2048x1536:
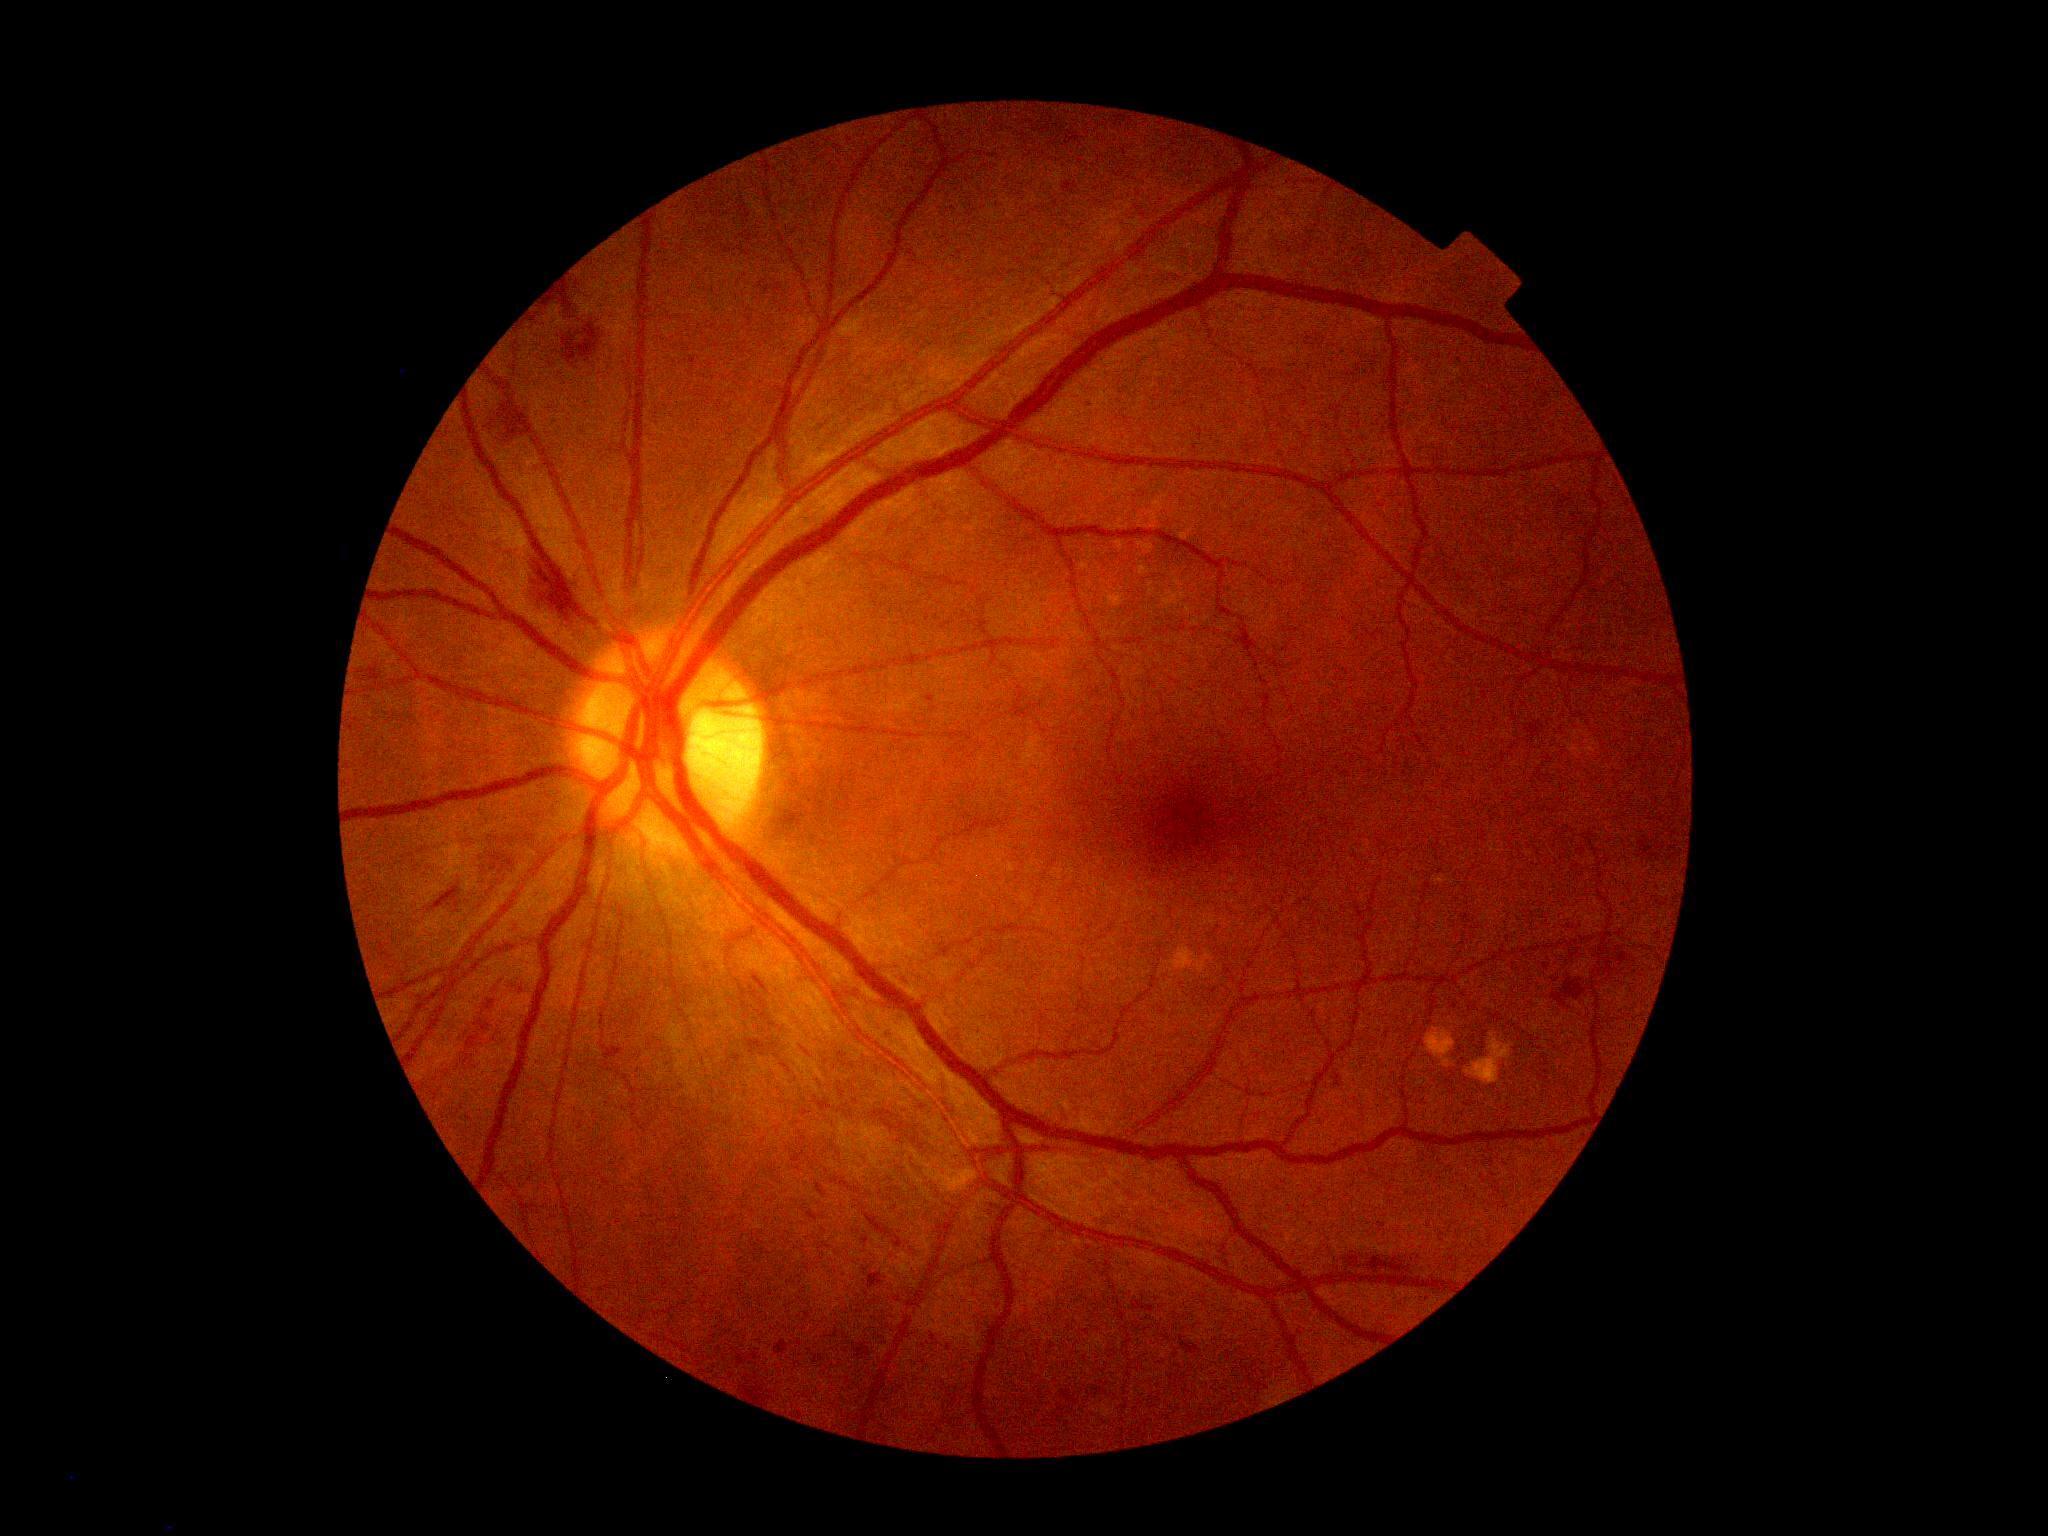 DR: moderate non-proliferative diabetic retinopathy (grade 2).